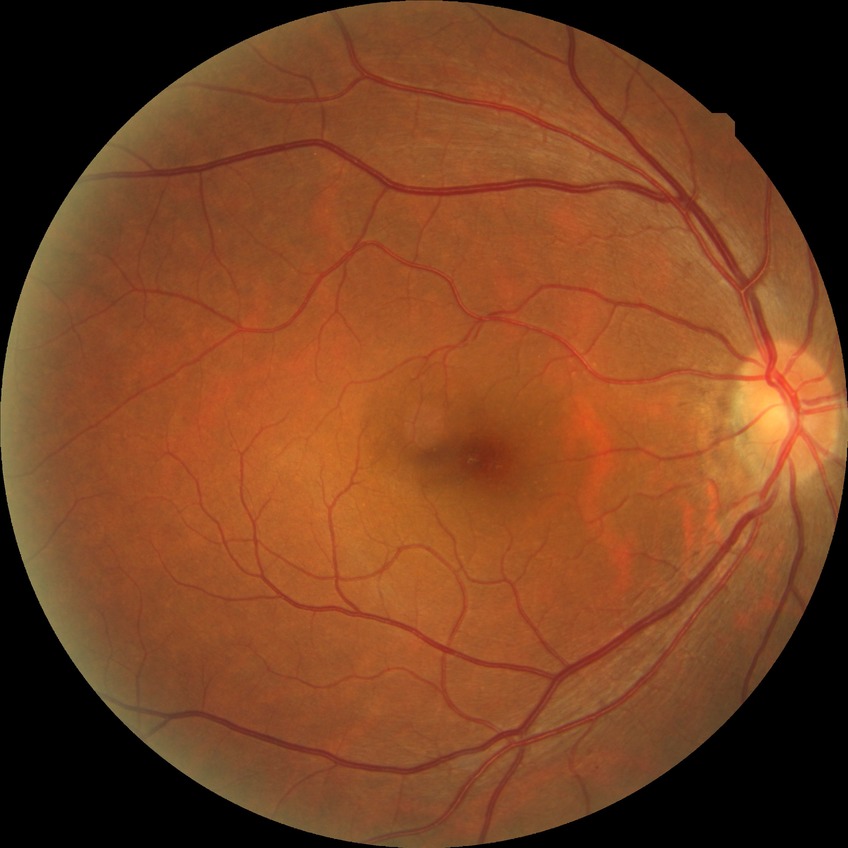

Diabetic retinopathy severity: no diabetic retinopathy.